Clarity RetCam 3, 130° FOV · 640 x 480 pixels · wide-field fundus photograph from neonatal ROP screening — 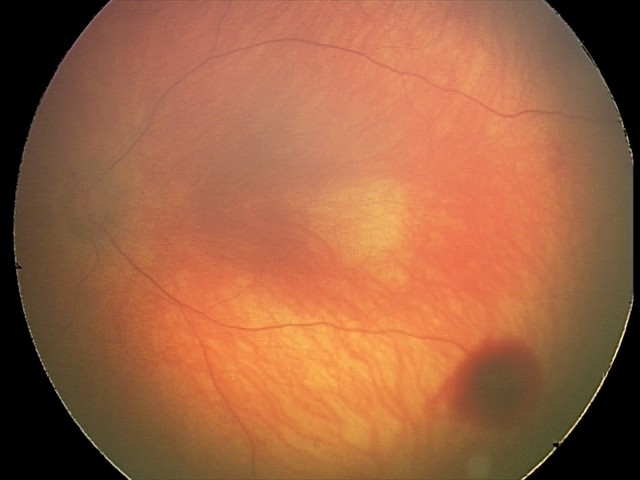 Screening series with retinal hemorrhages.